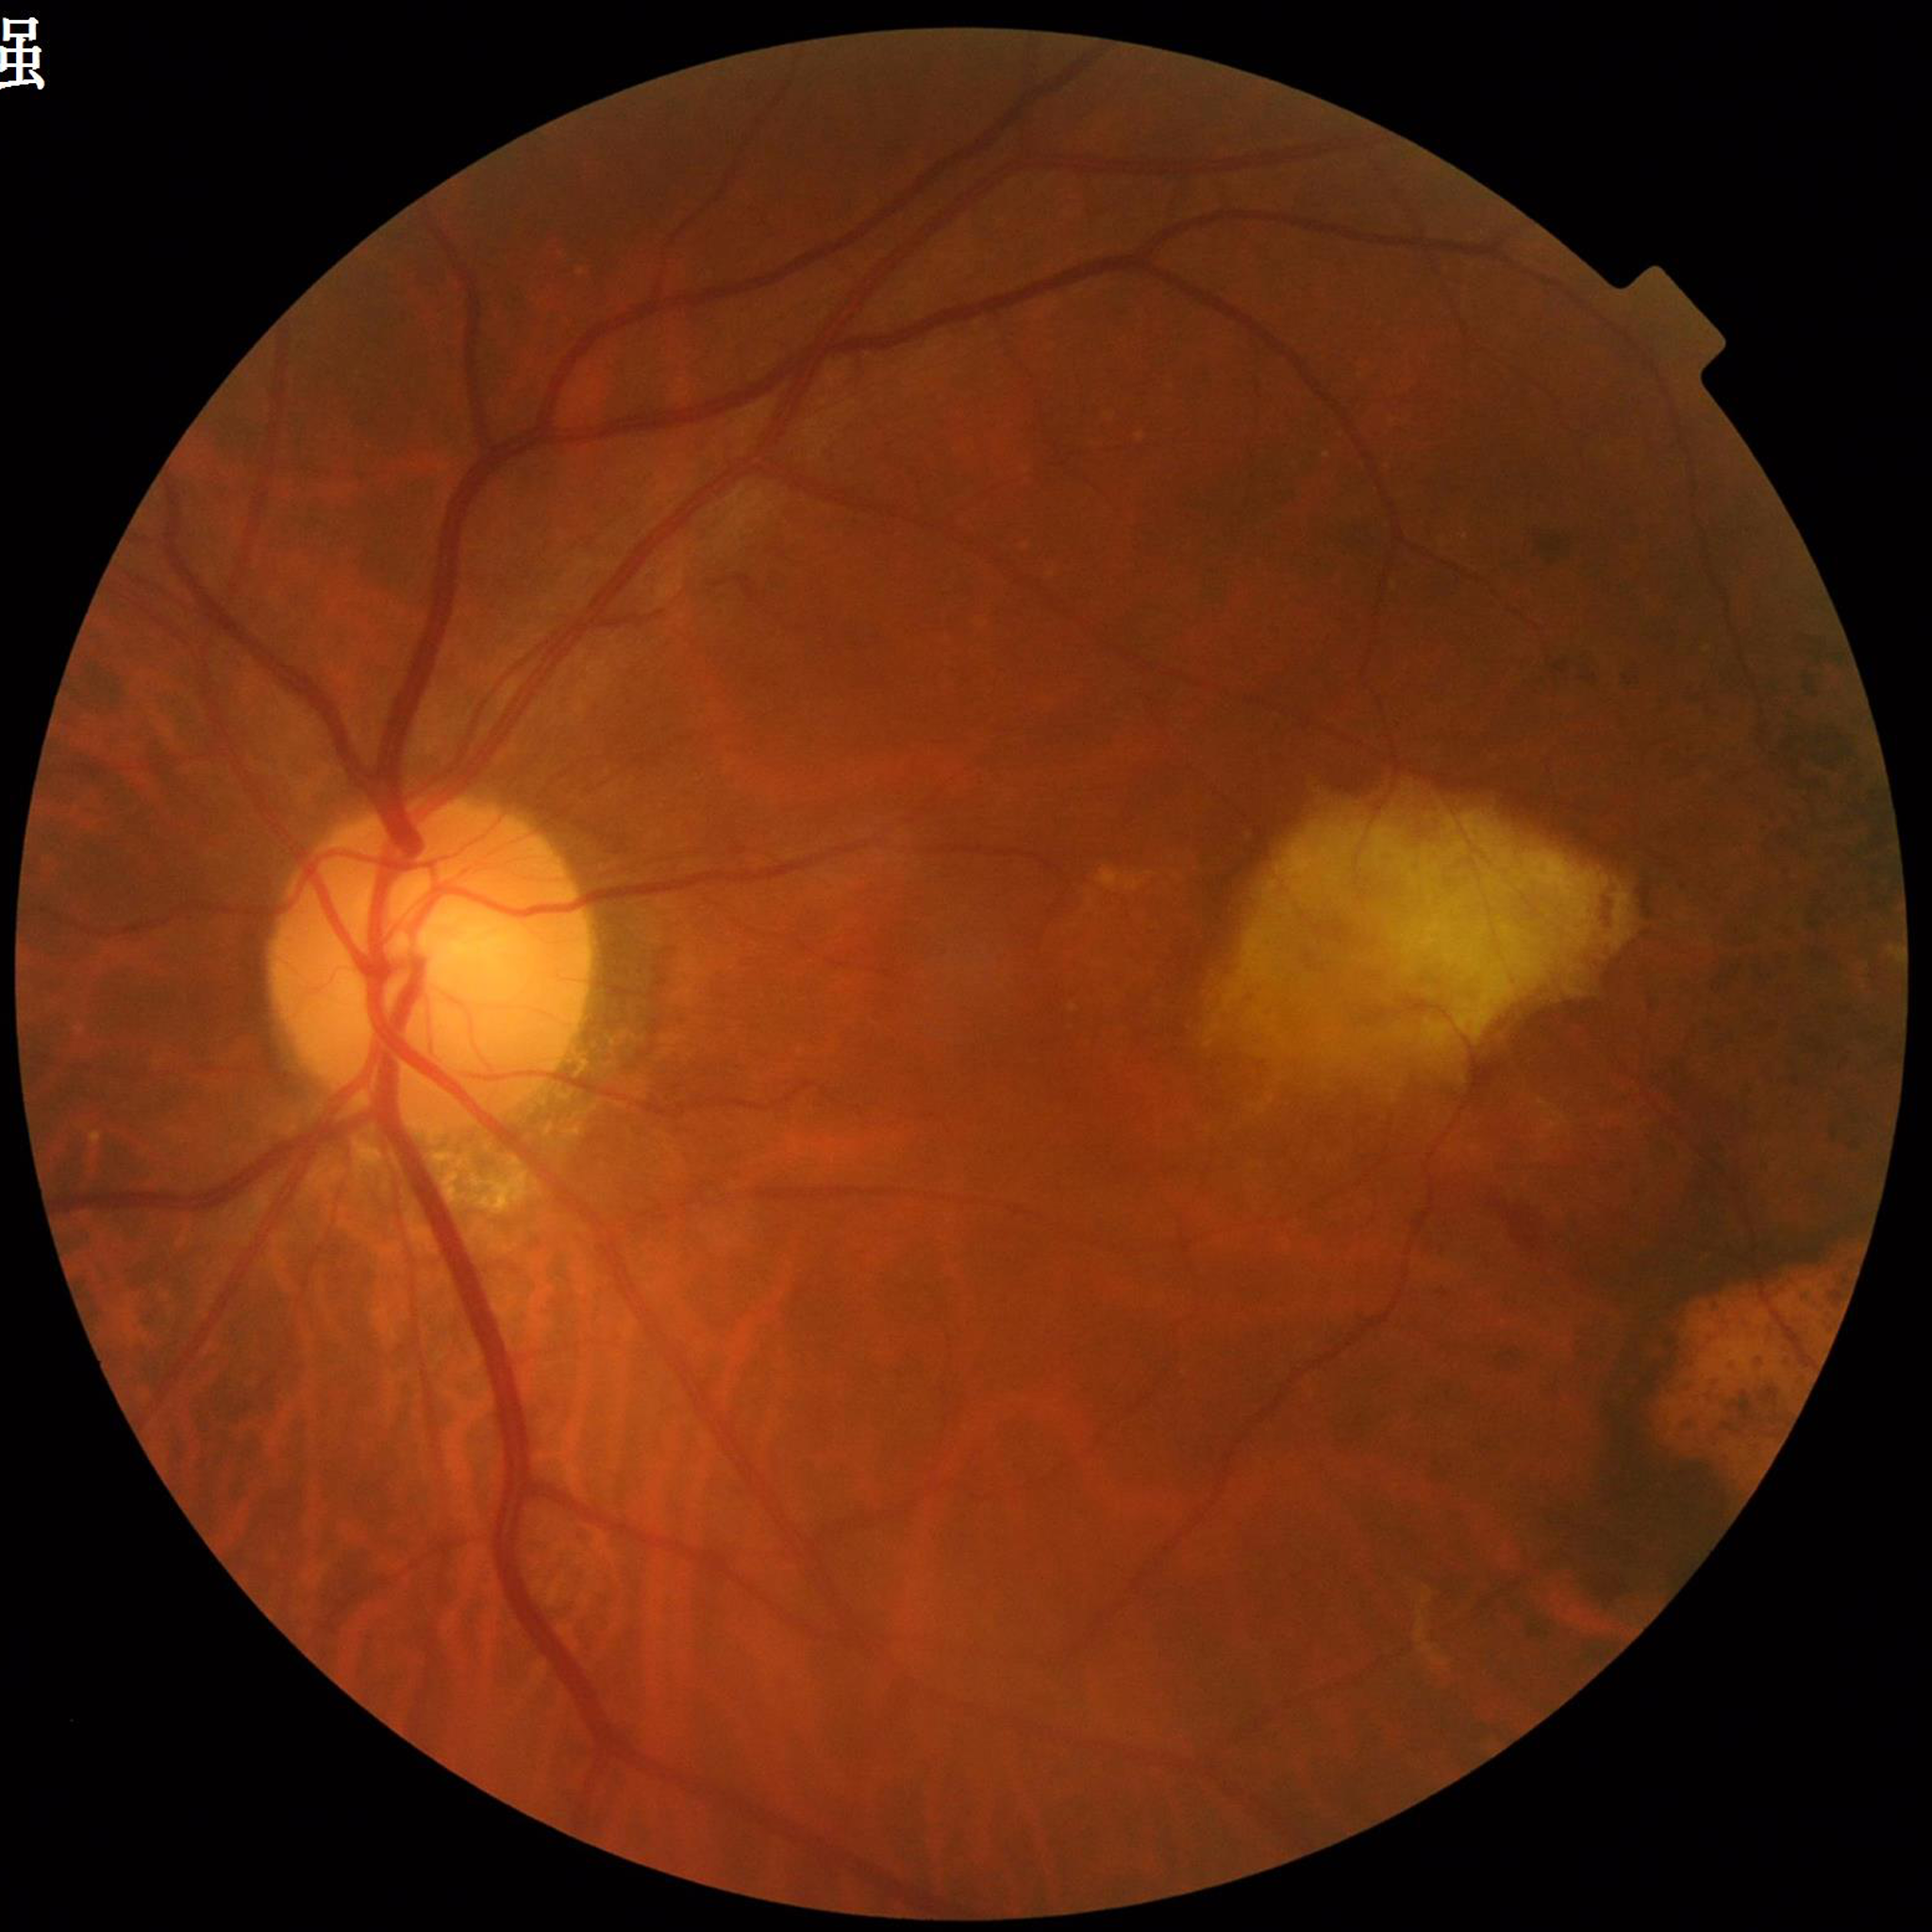
Fundus image of an eye with AMD. Quality assessment: satisfactory.